Intraocular pressure 24 mmHg (applanation tonometry) · color fundus image · patient age: 73 years · central corneal thickness: 550 µm · 2212x1661px · axial length (AL) 22.67 mm
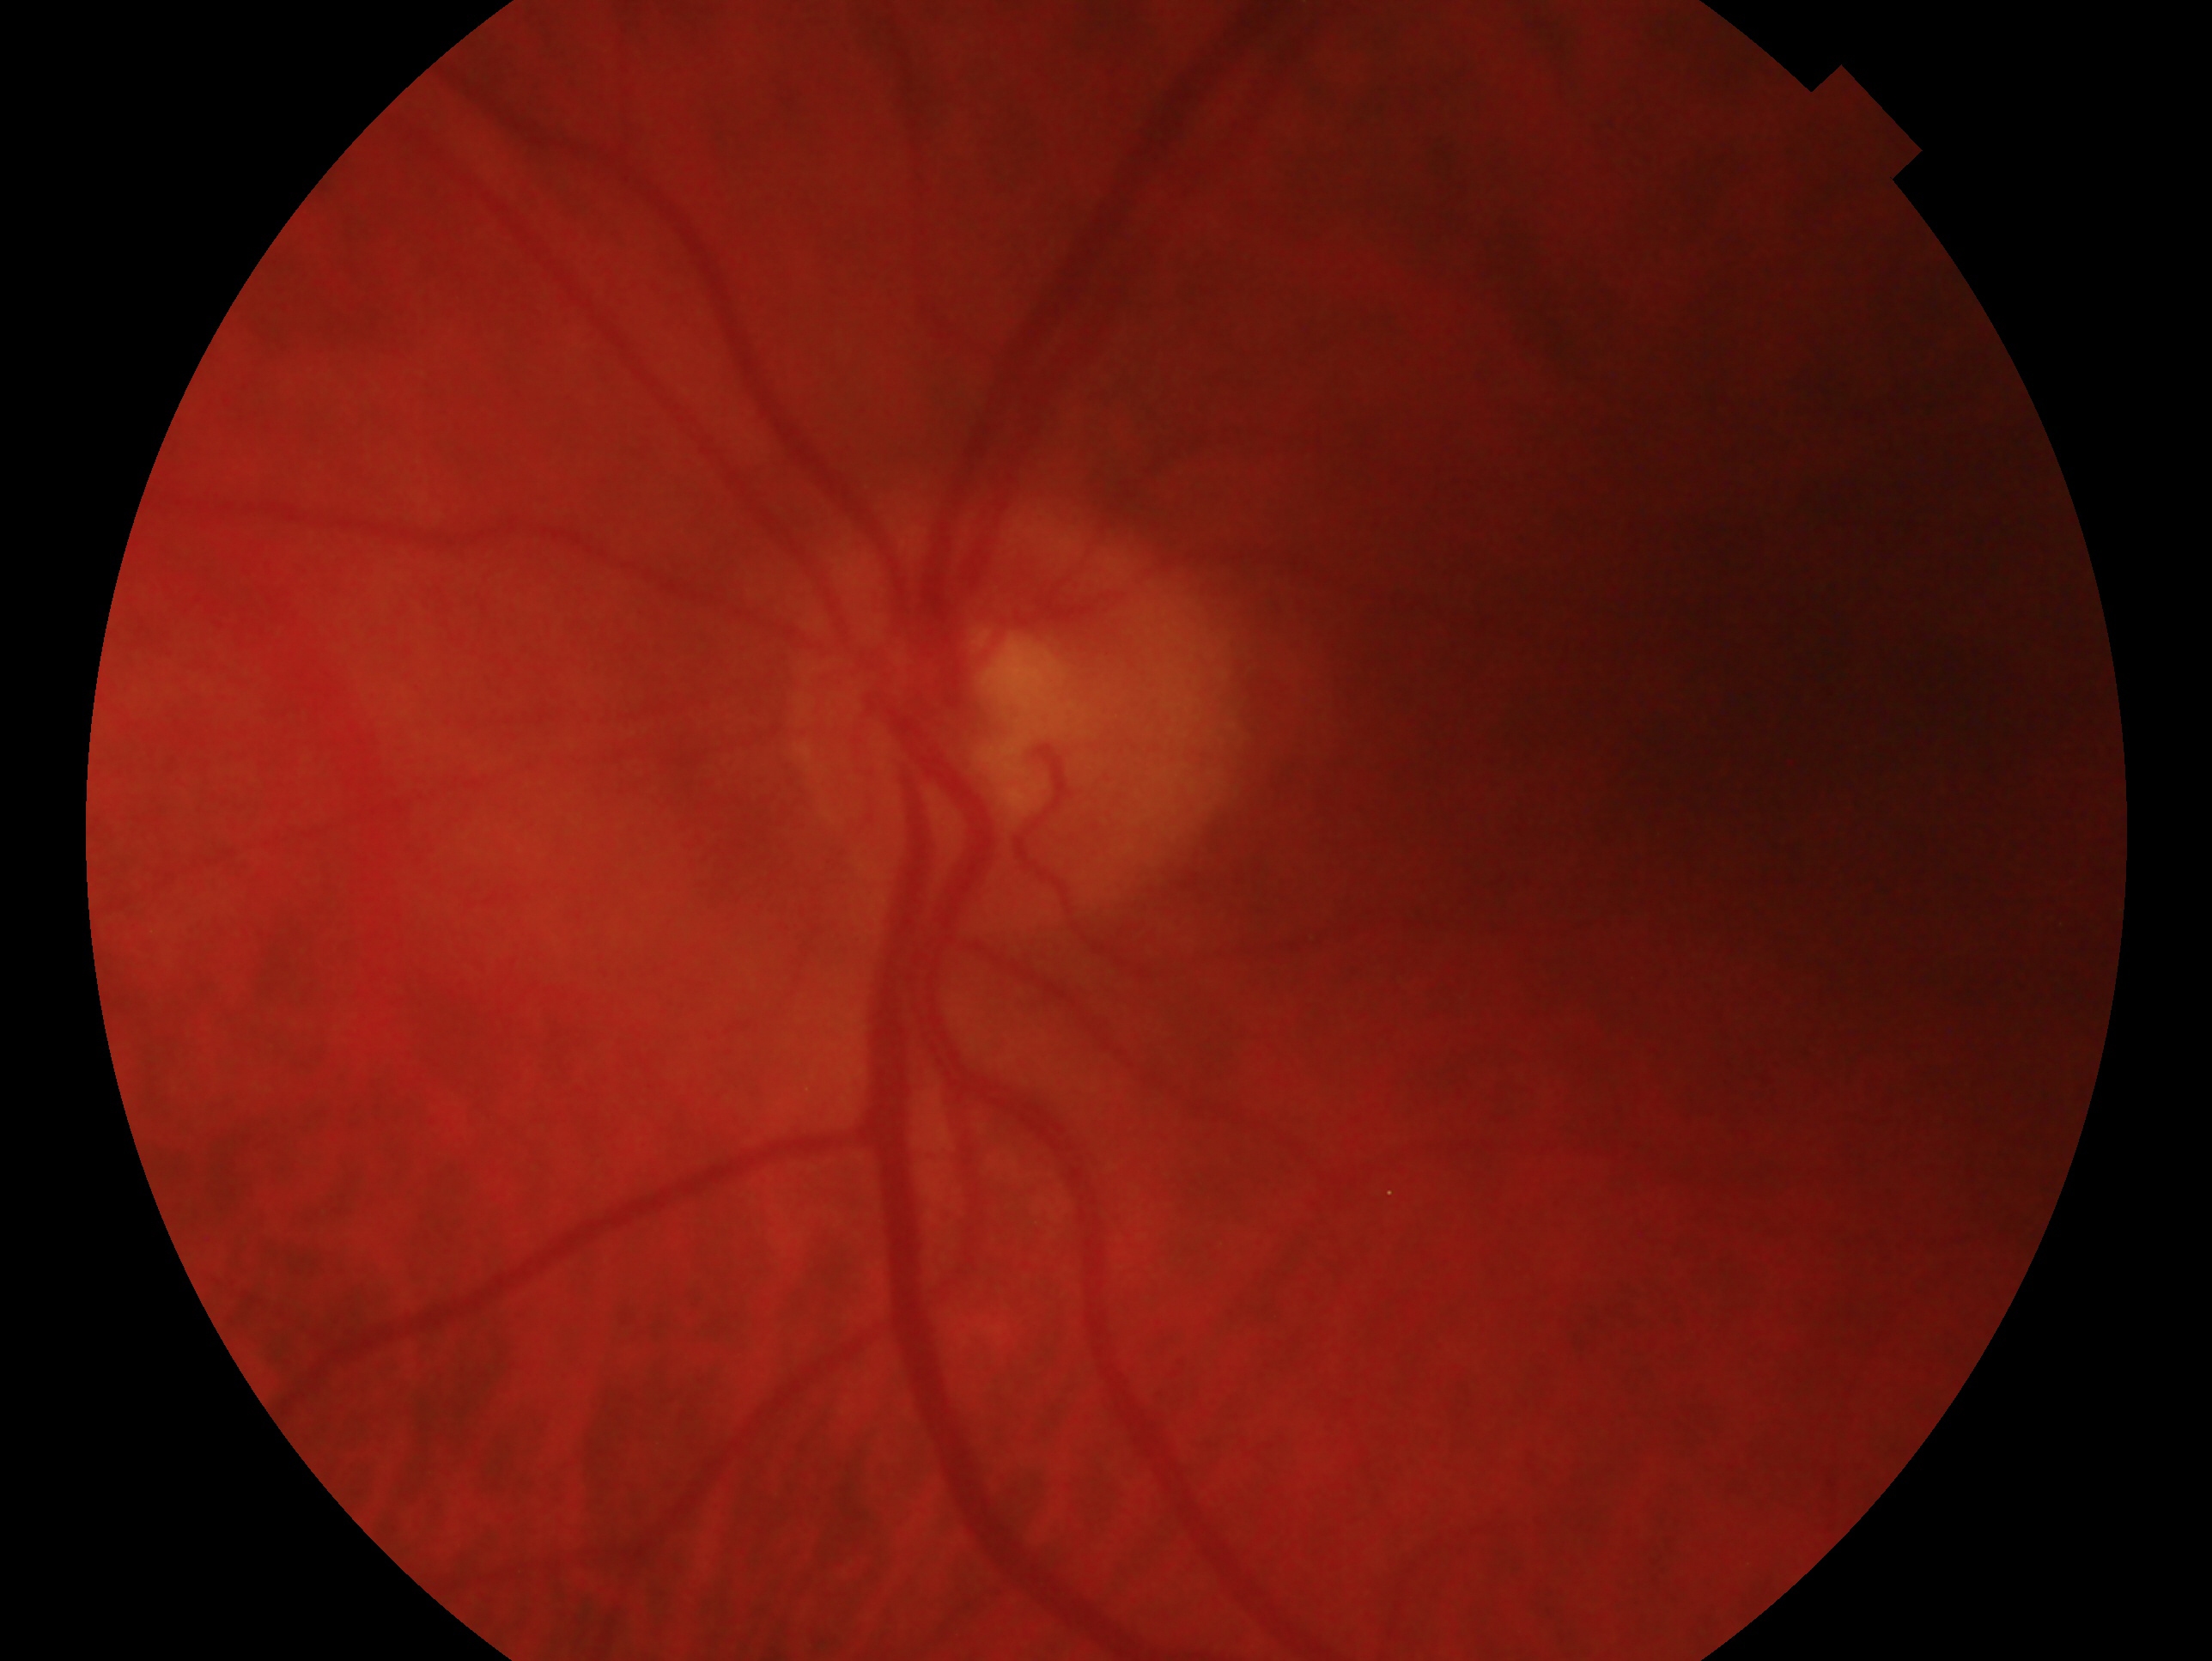

Eye: OS.
Assessment — glaucomatous optic neuropathy.